1440 x 1080 pixels; wide-field fundus photograph from neonatal ROP screening — 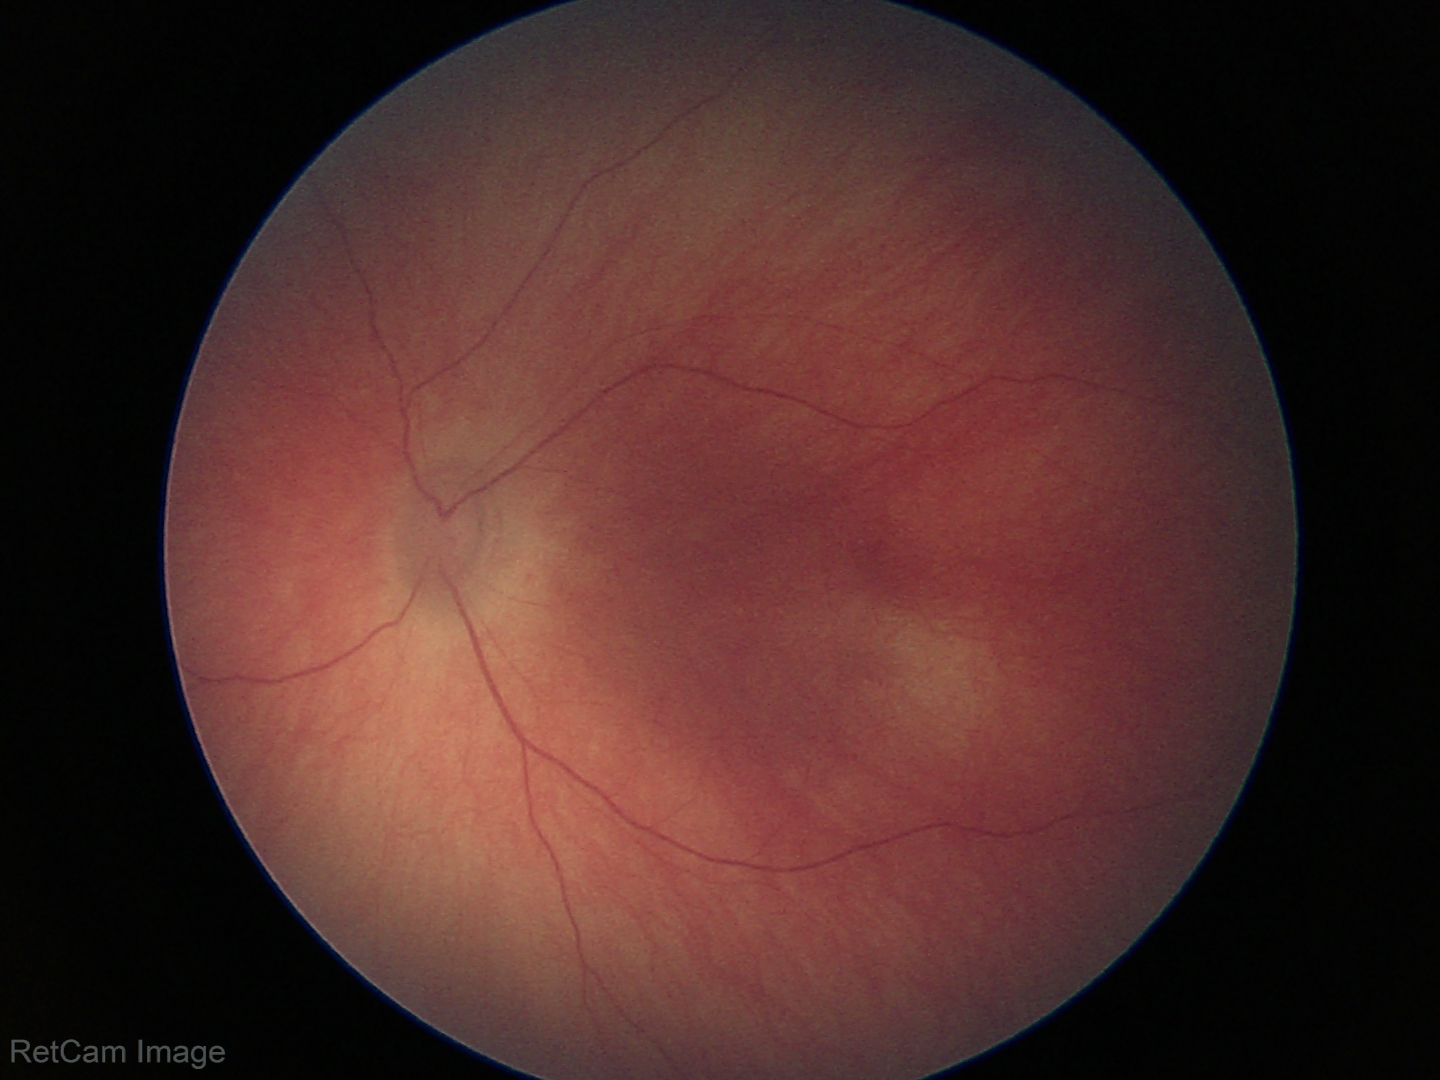
Diagnosis: no pathology identified.